Modified Davis classification: 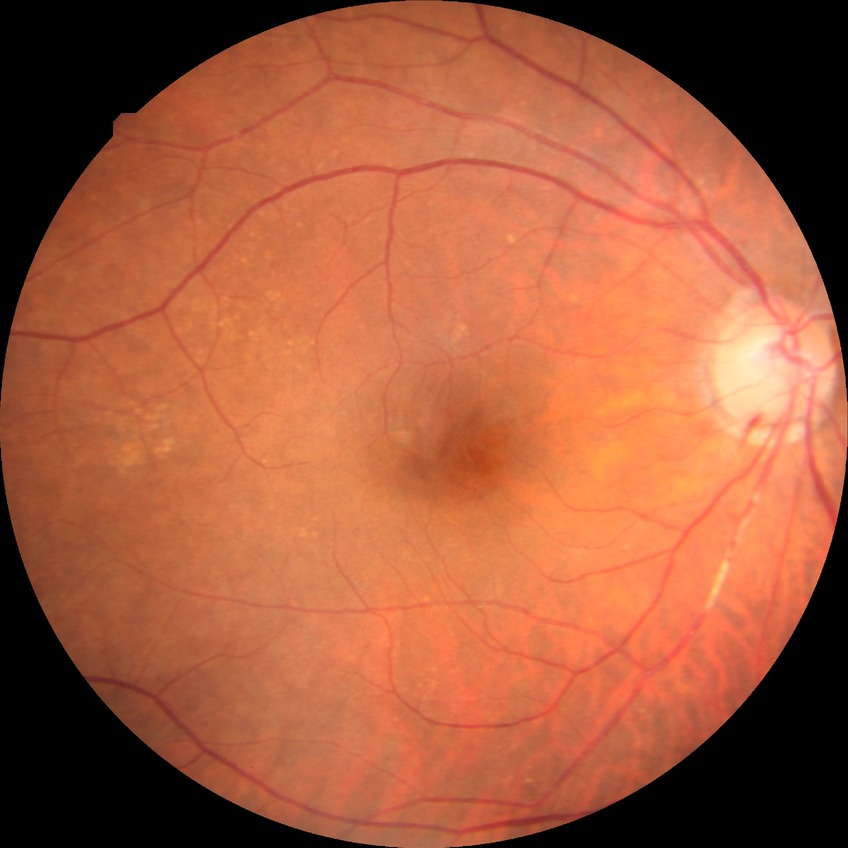 DR stage: NDR. No signs of diabetic retinopathy.